1240 by 1240 pixels · infant wide-field retinal image:
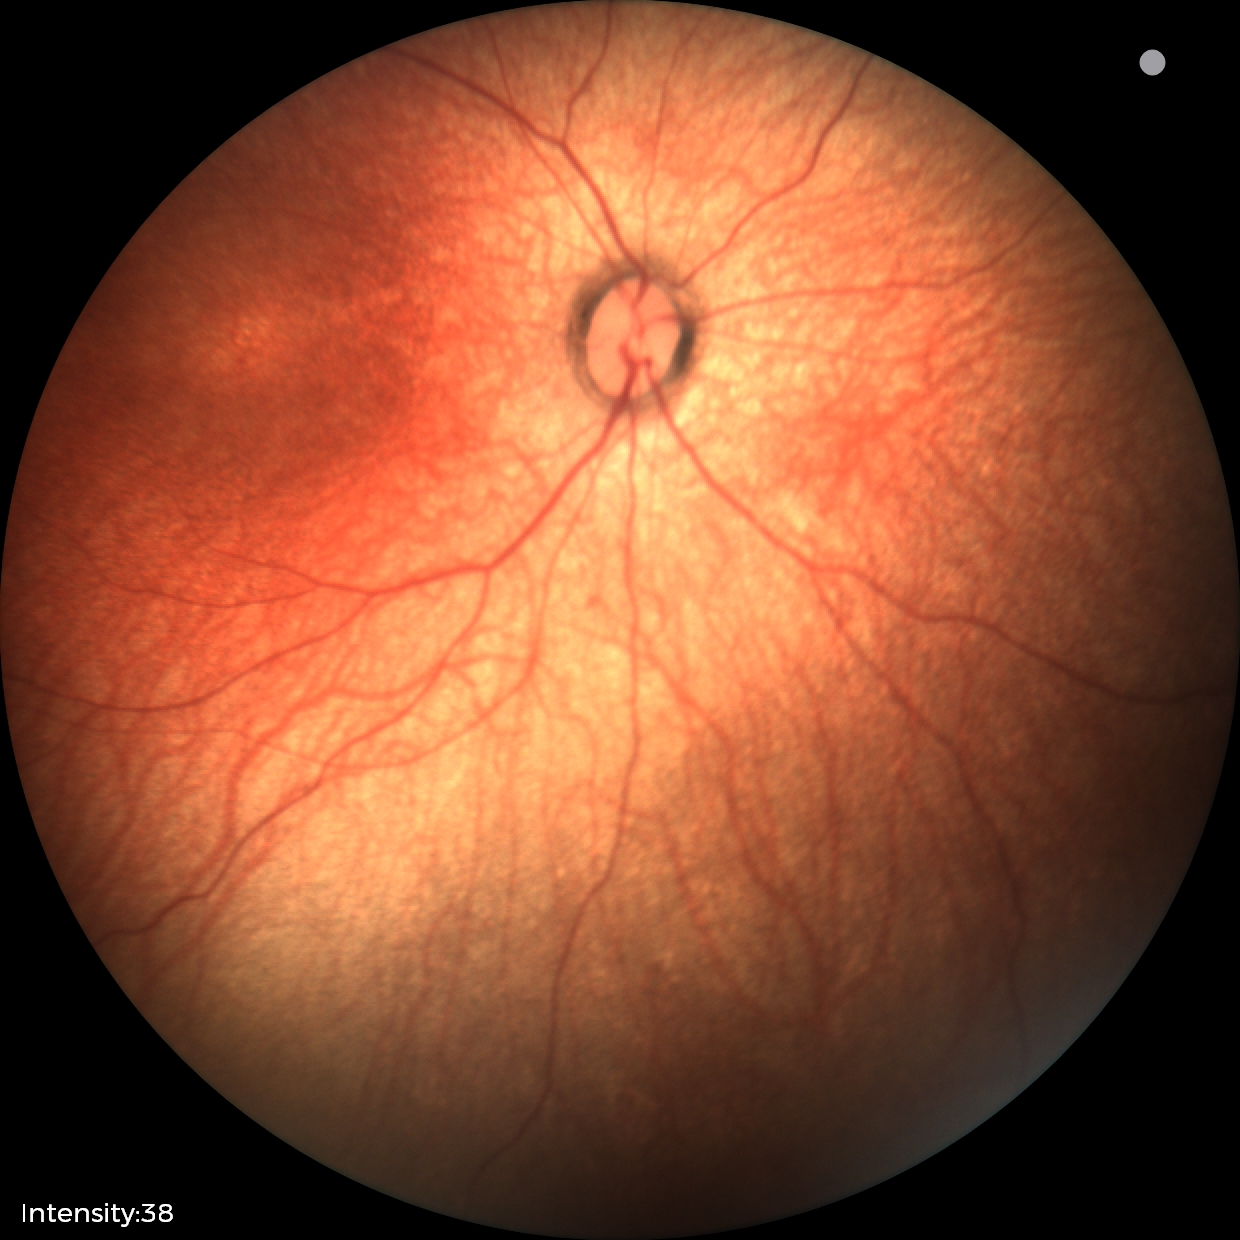
No retinal pathology identified on screening.